Captured after pupil dilation:
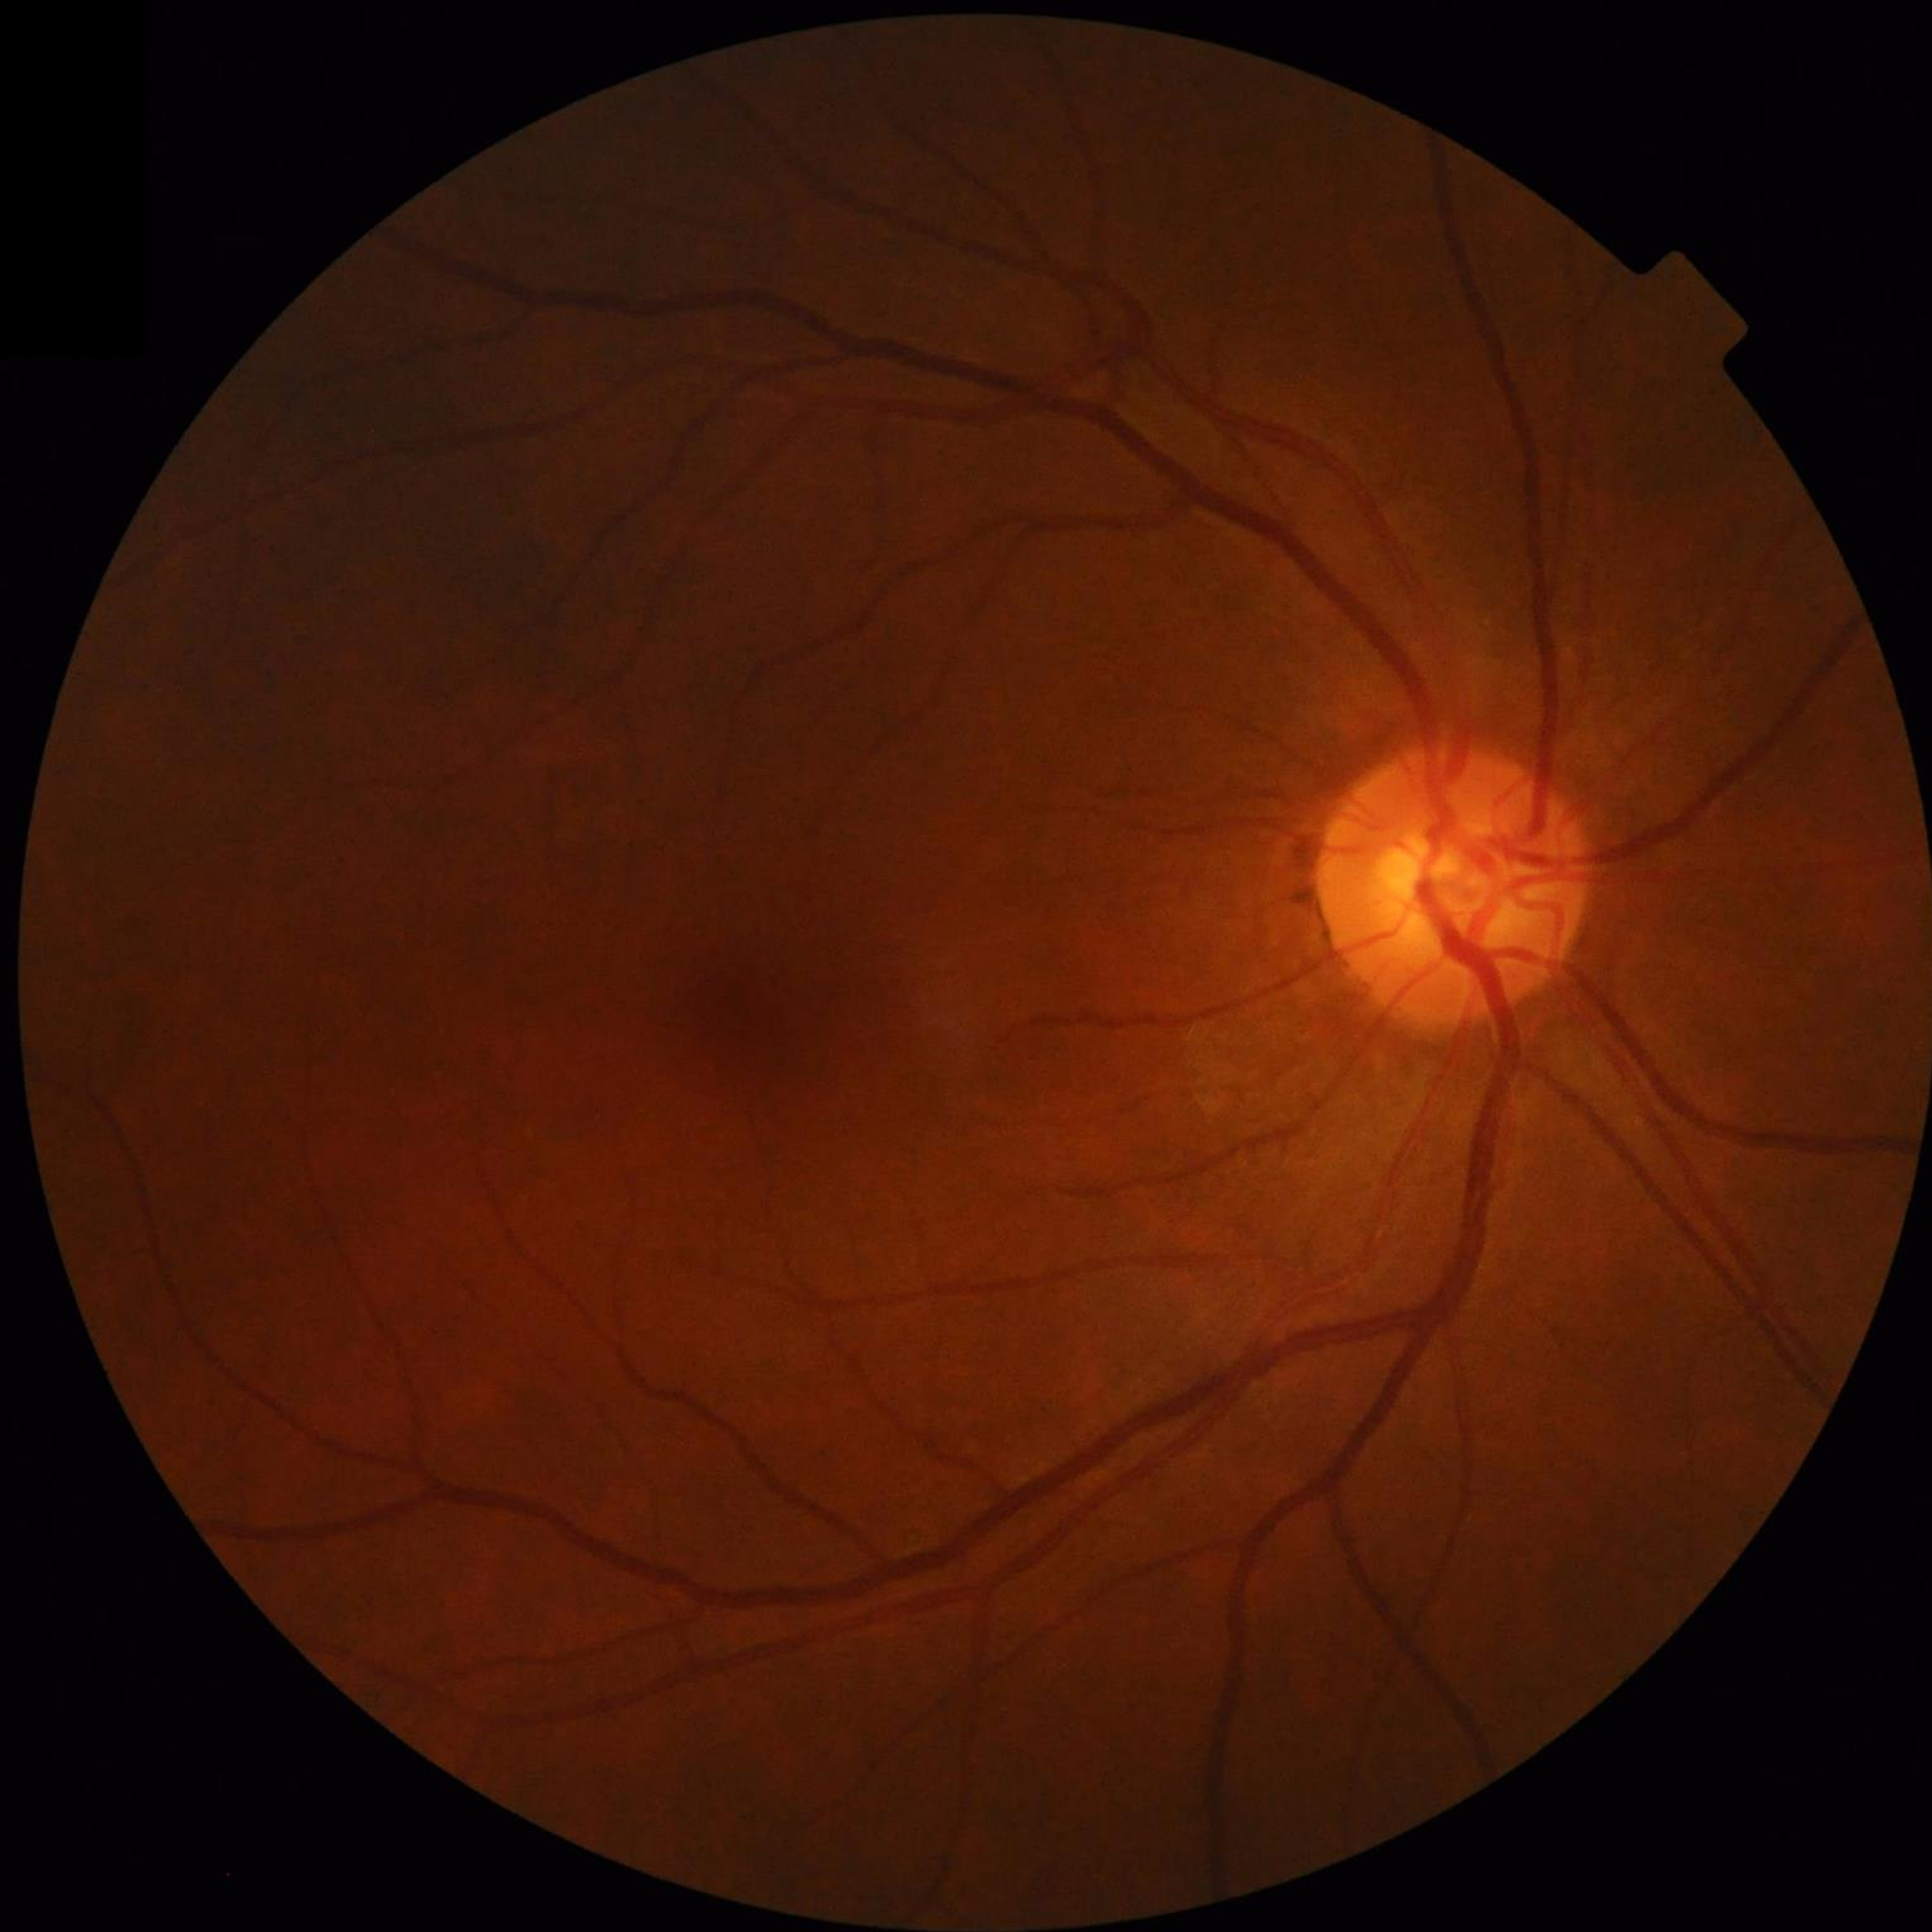 Control patient without diagnosed AMD, DR, or glaucoma. Automated quality assessment: contrast adequate, no blur, illumination and color satisfactory.